NIDEK AFC-230 — 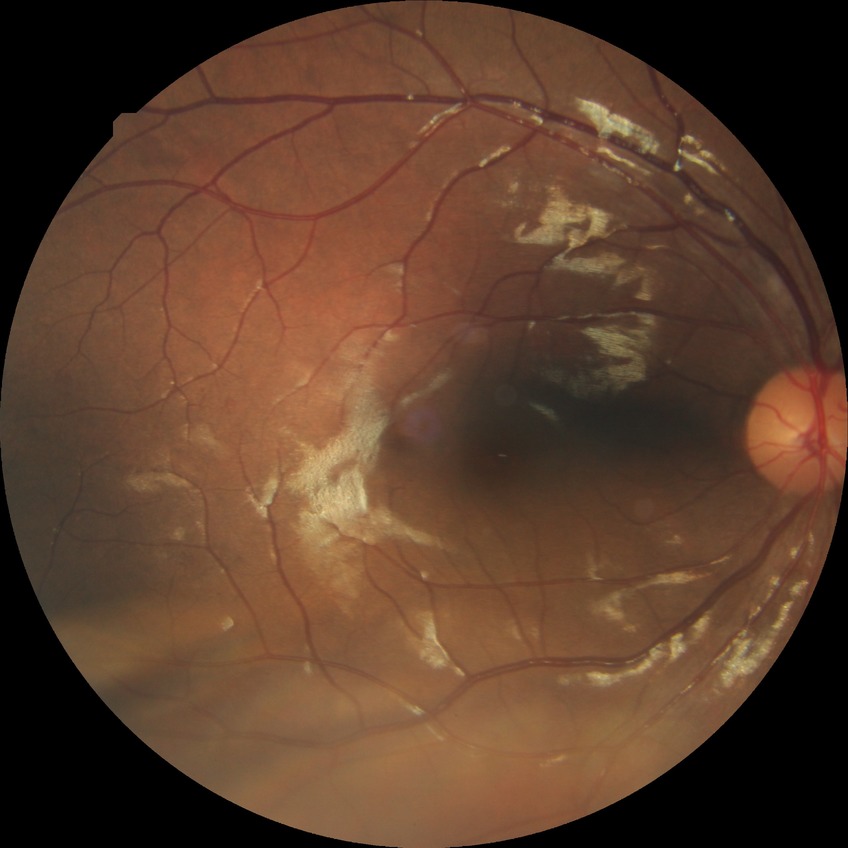
• DR impression: no apparent DR
• Davis DR grade: NDR